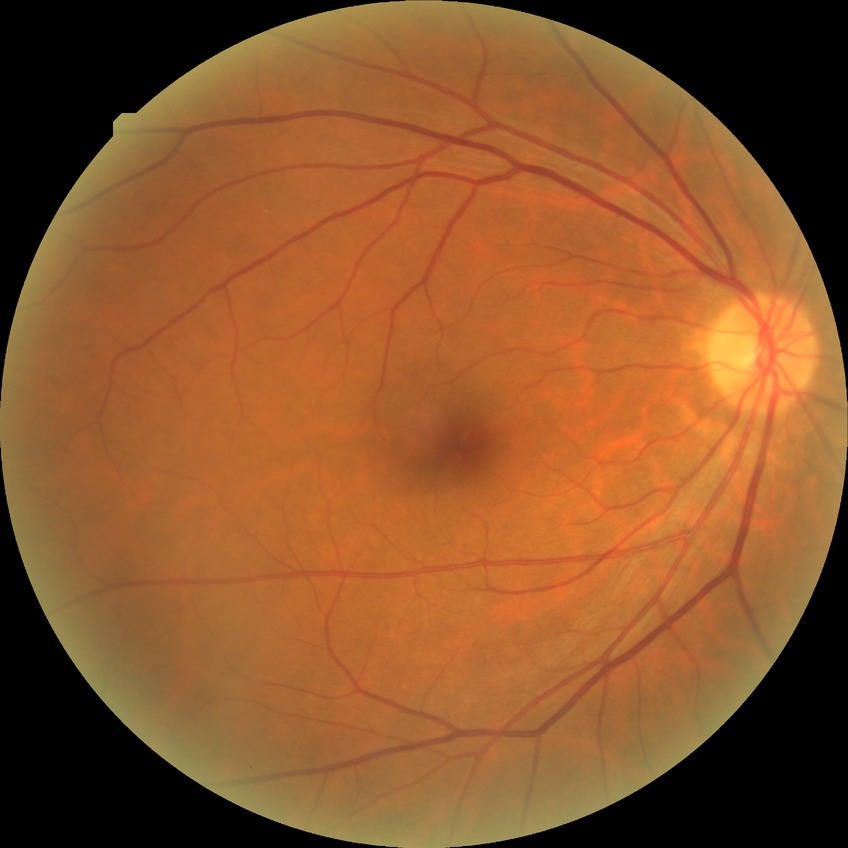   davis_grade: no diabetic retinopathy